Retinal fundus photograph, Davis DR grading
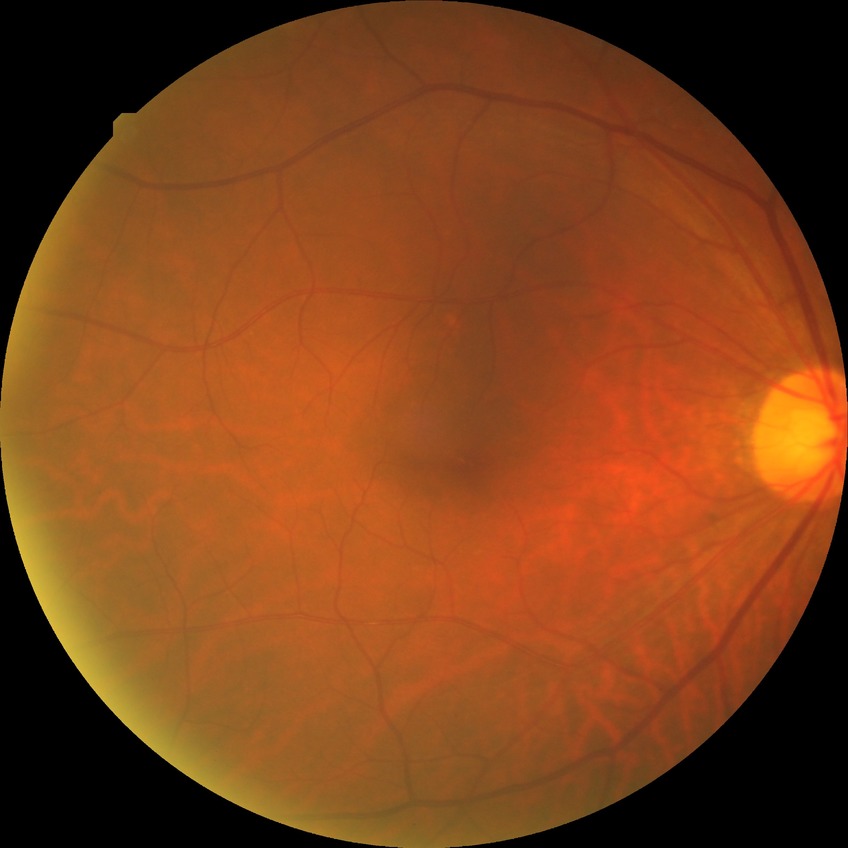

modified Davis grading@no diabetic retinopathy.